Acquired with a NIDEK AFC-230; diabetic retinopathy graded by the modified Davis classification; 45° FOV; 848 x 848 pixels; posterior pole color fundus photograph; no pharmacologic dilation
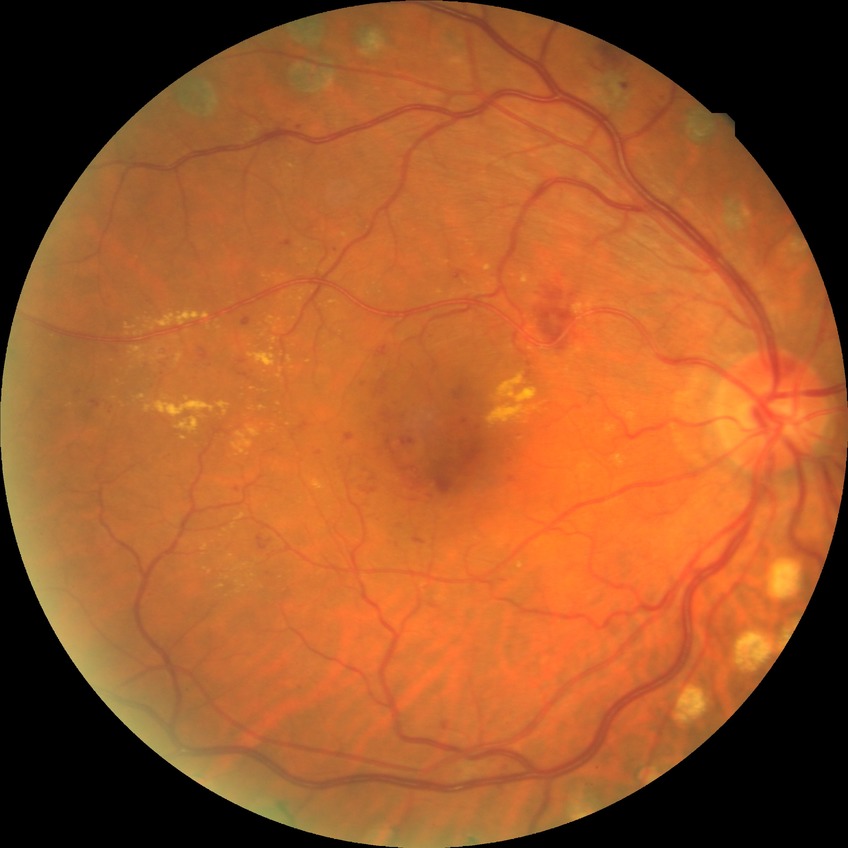

diabetic retinopathy (DR)=simple diabetic retinopathy (SDR).